Phoenix ICON, 100° FOV · Phoenix ICON wide-field infant fundus image.
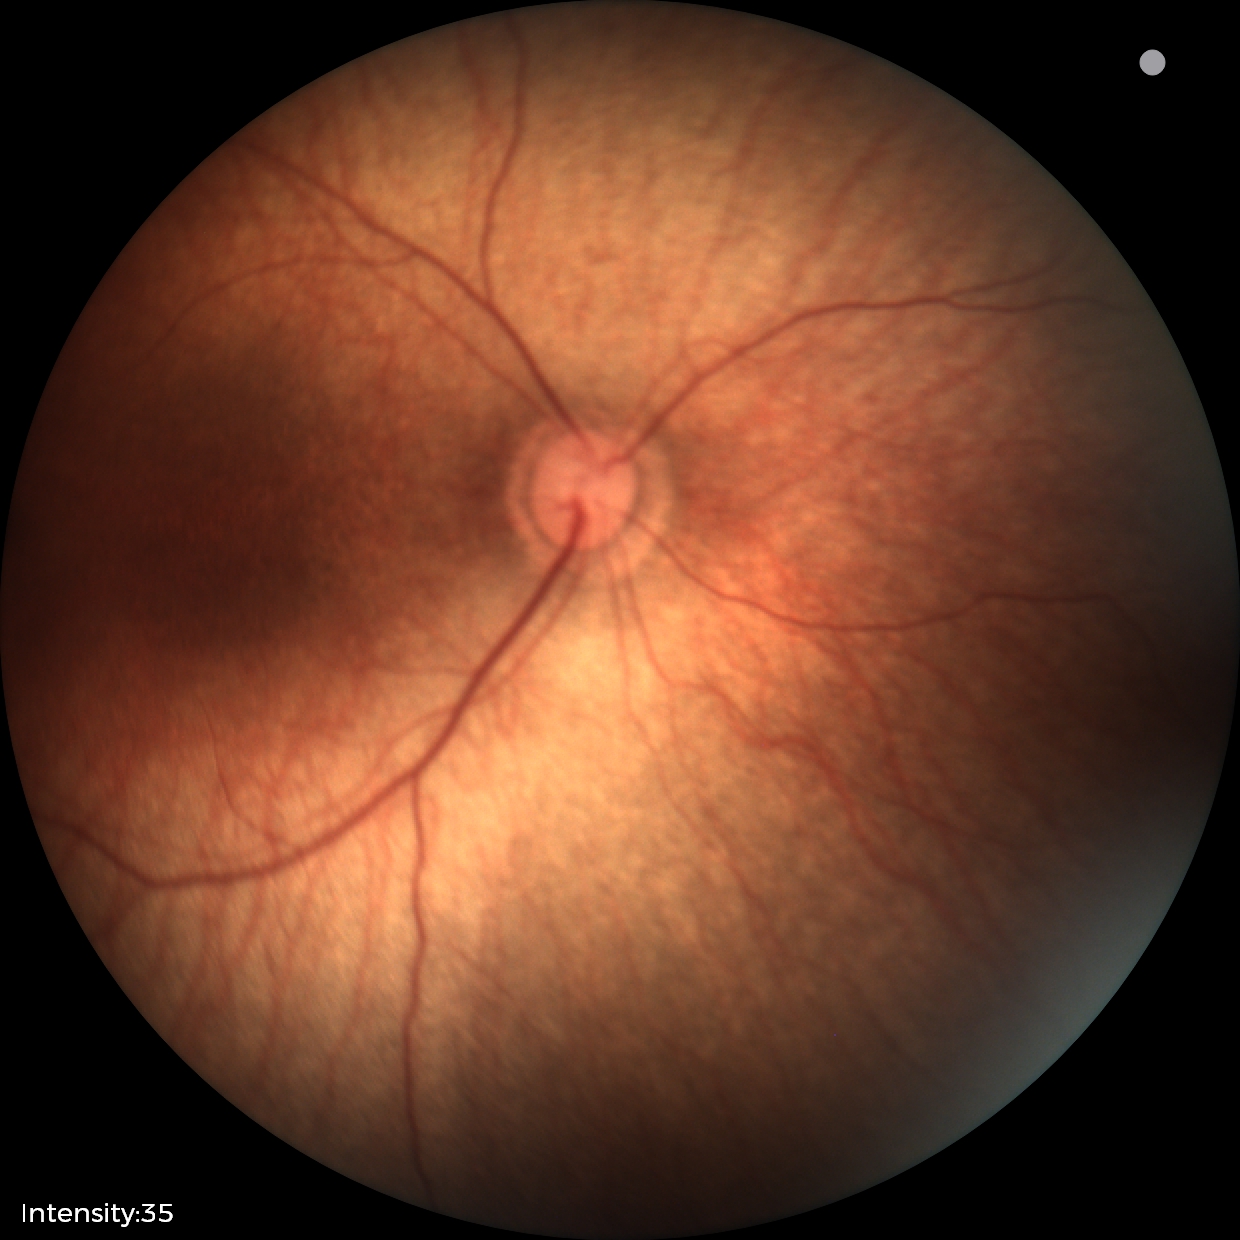 Normal screening examination.